848x848. Camera: NIDEK AFC-230. 45° FOV
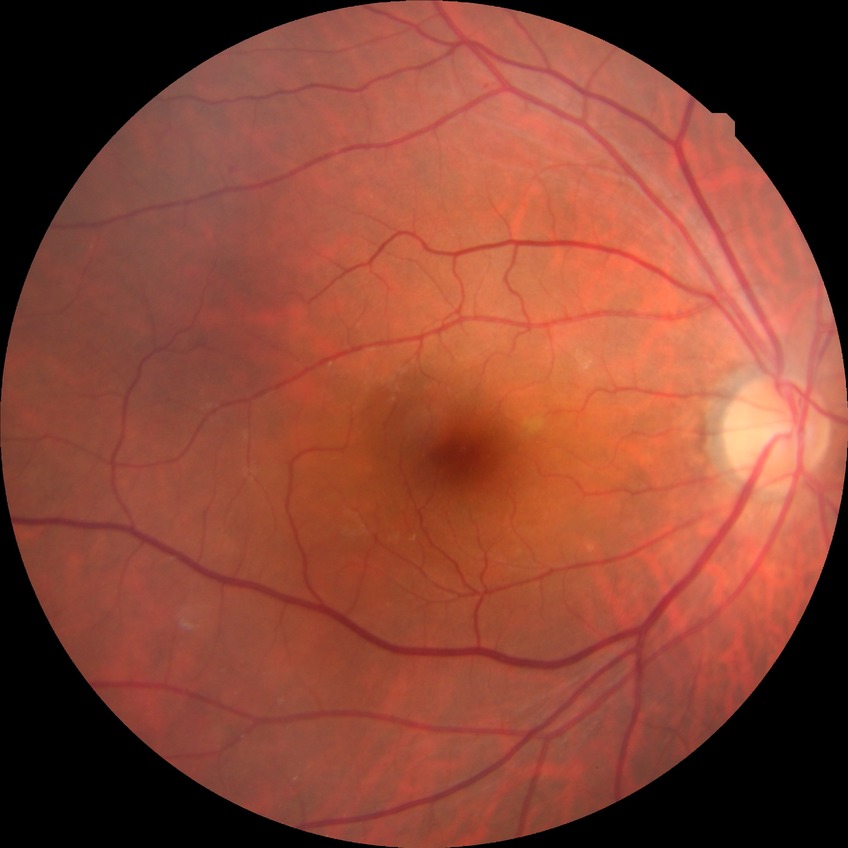 Diabetic retinopathy (DR): NDR (no diabetic retinopathy).